848x848 · without pupil dilation · 45° FOV.
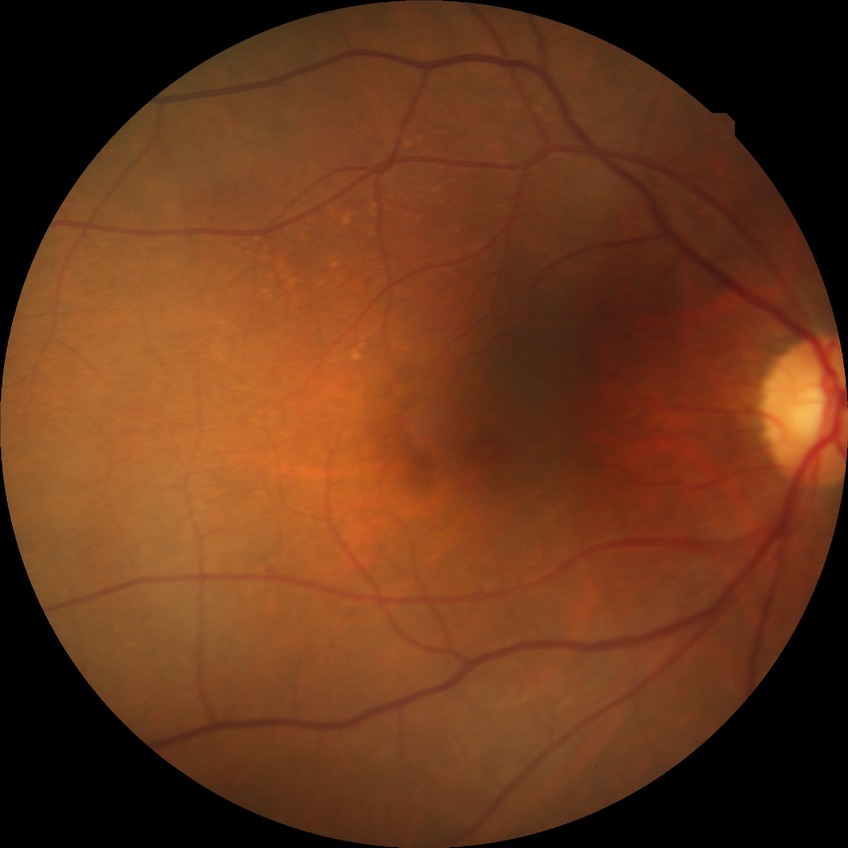   davis_grade: no diabetic retinopathy (NDR)